1960x1897: 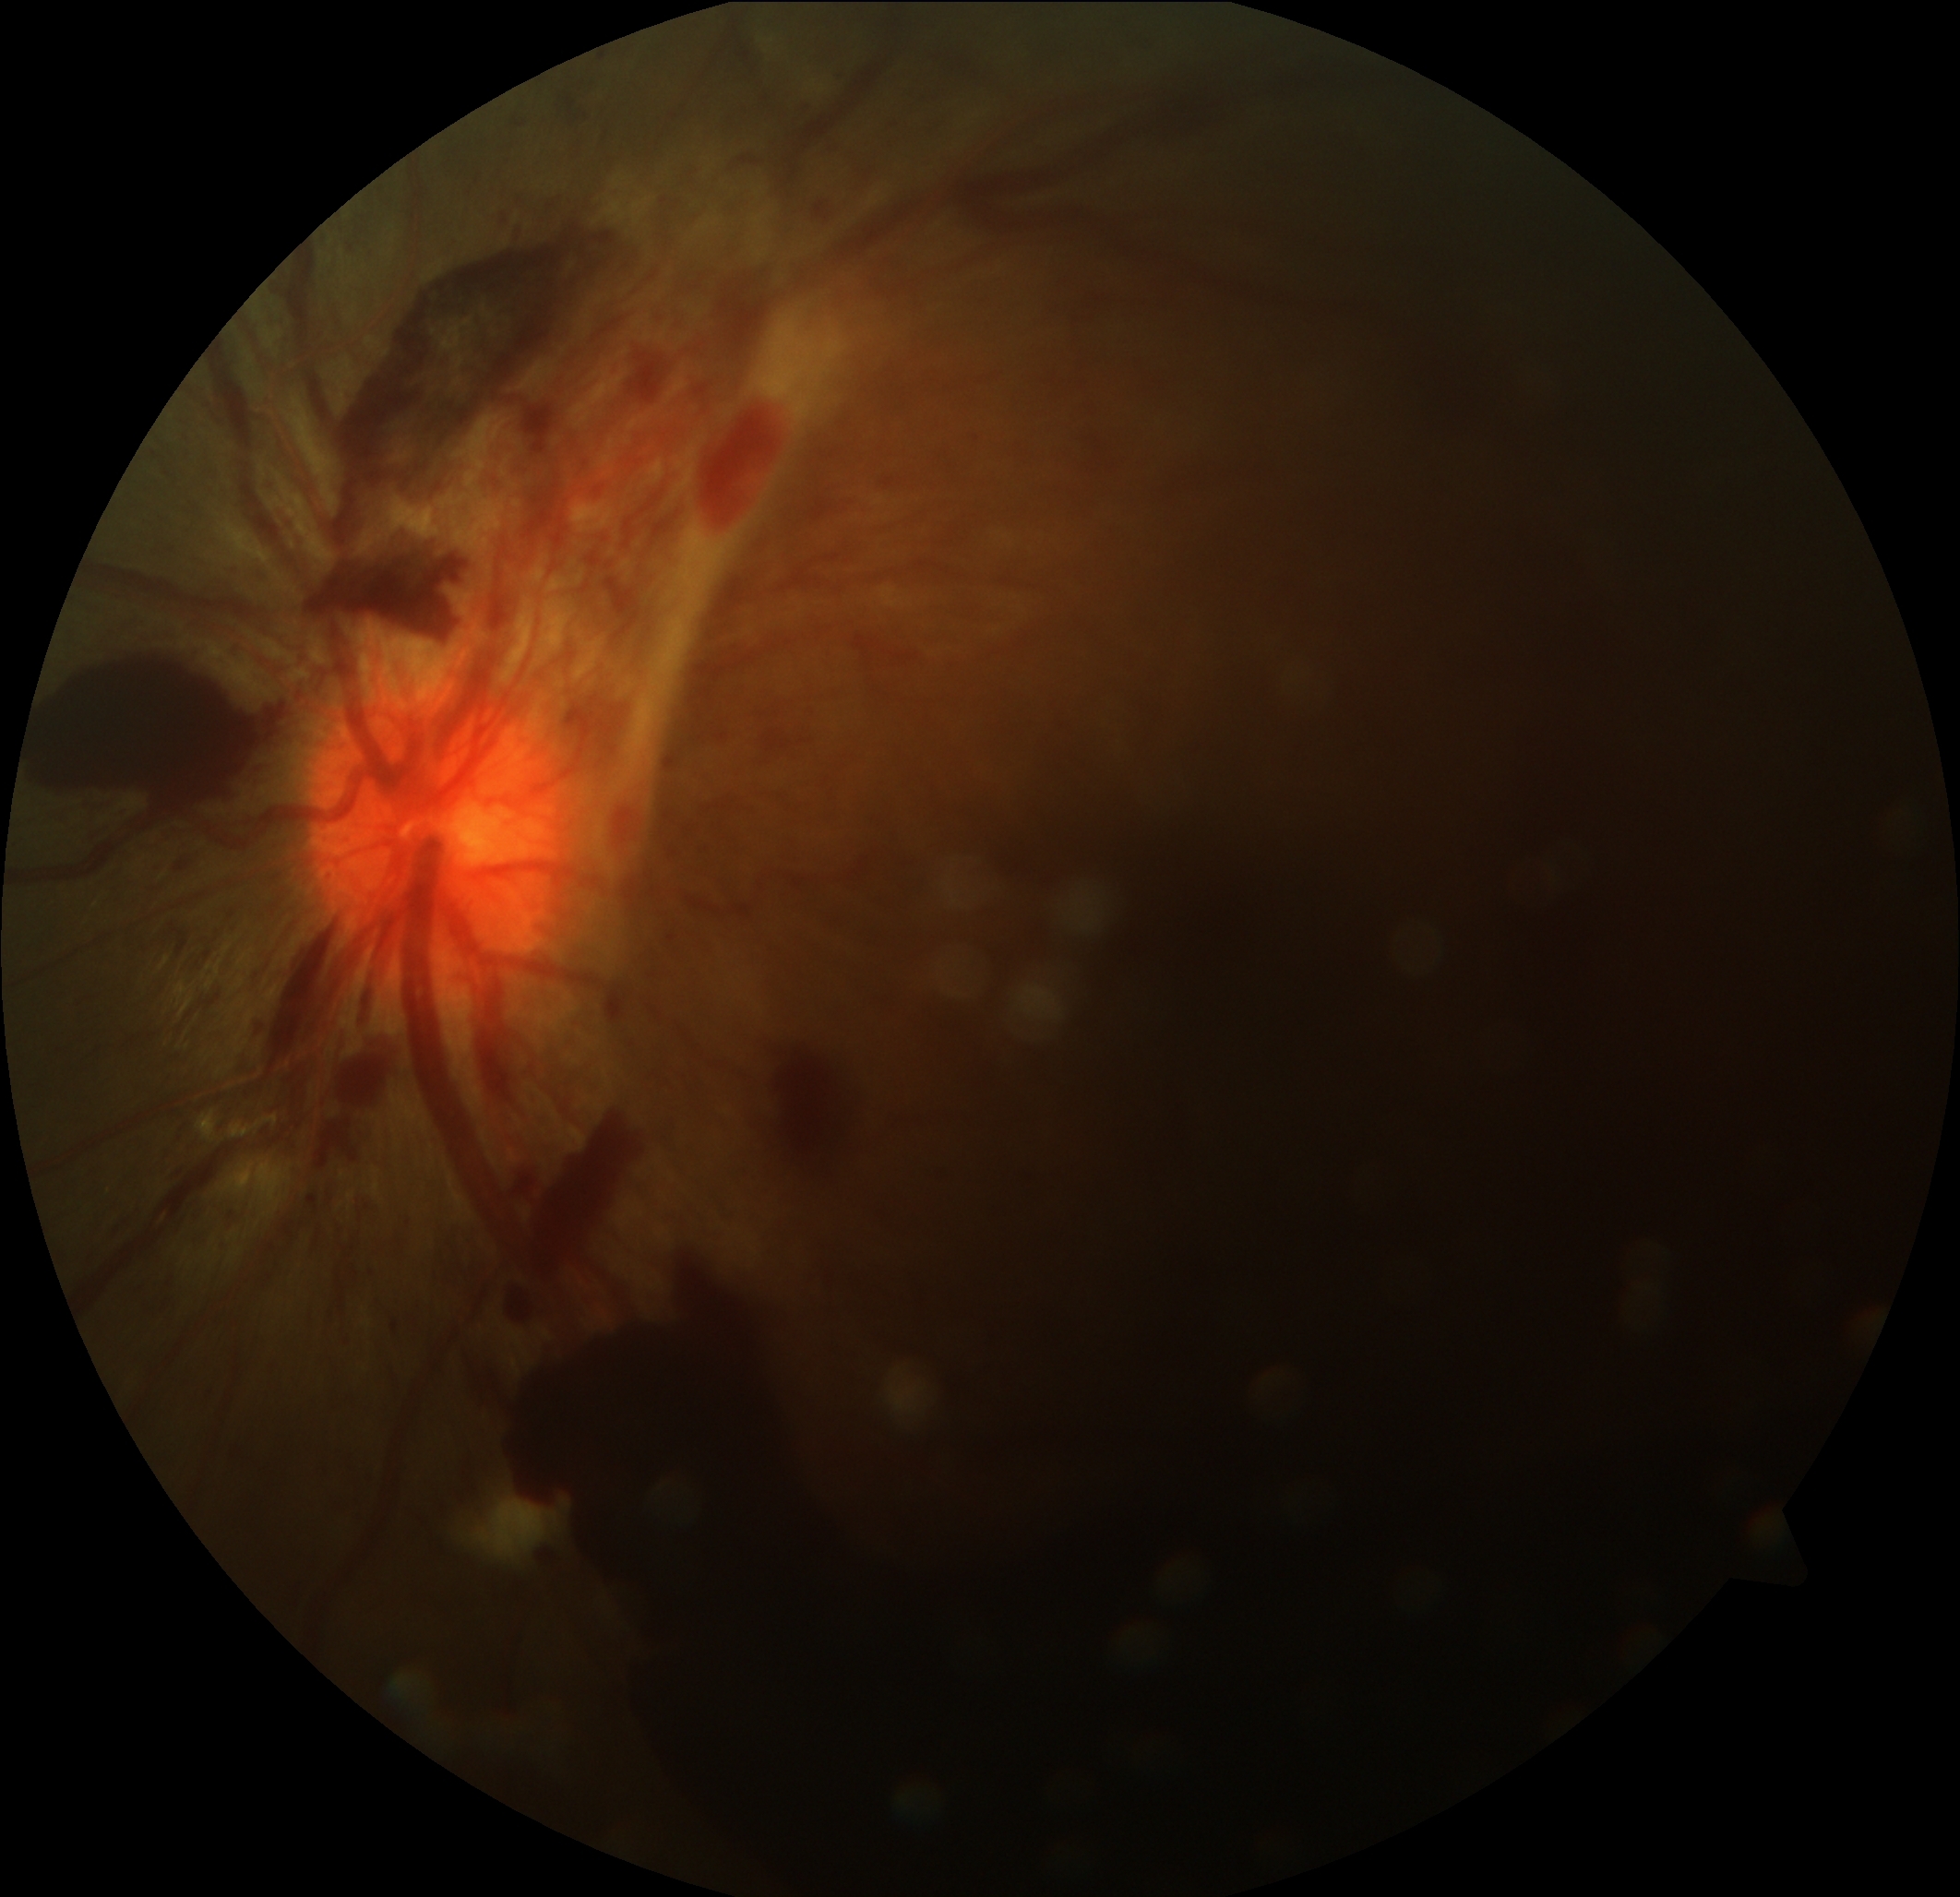 Retinopathy is grade 4.